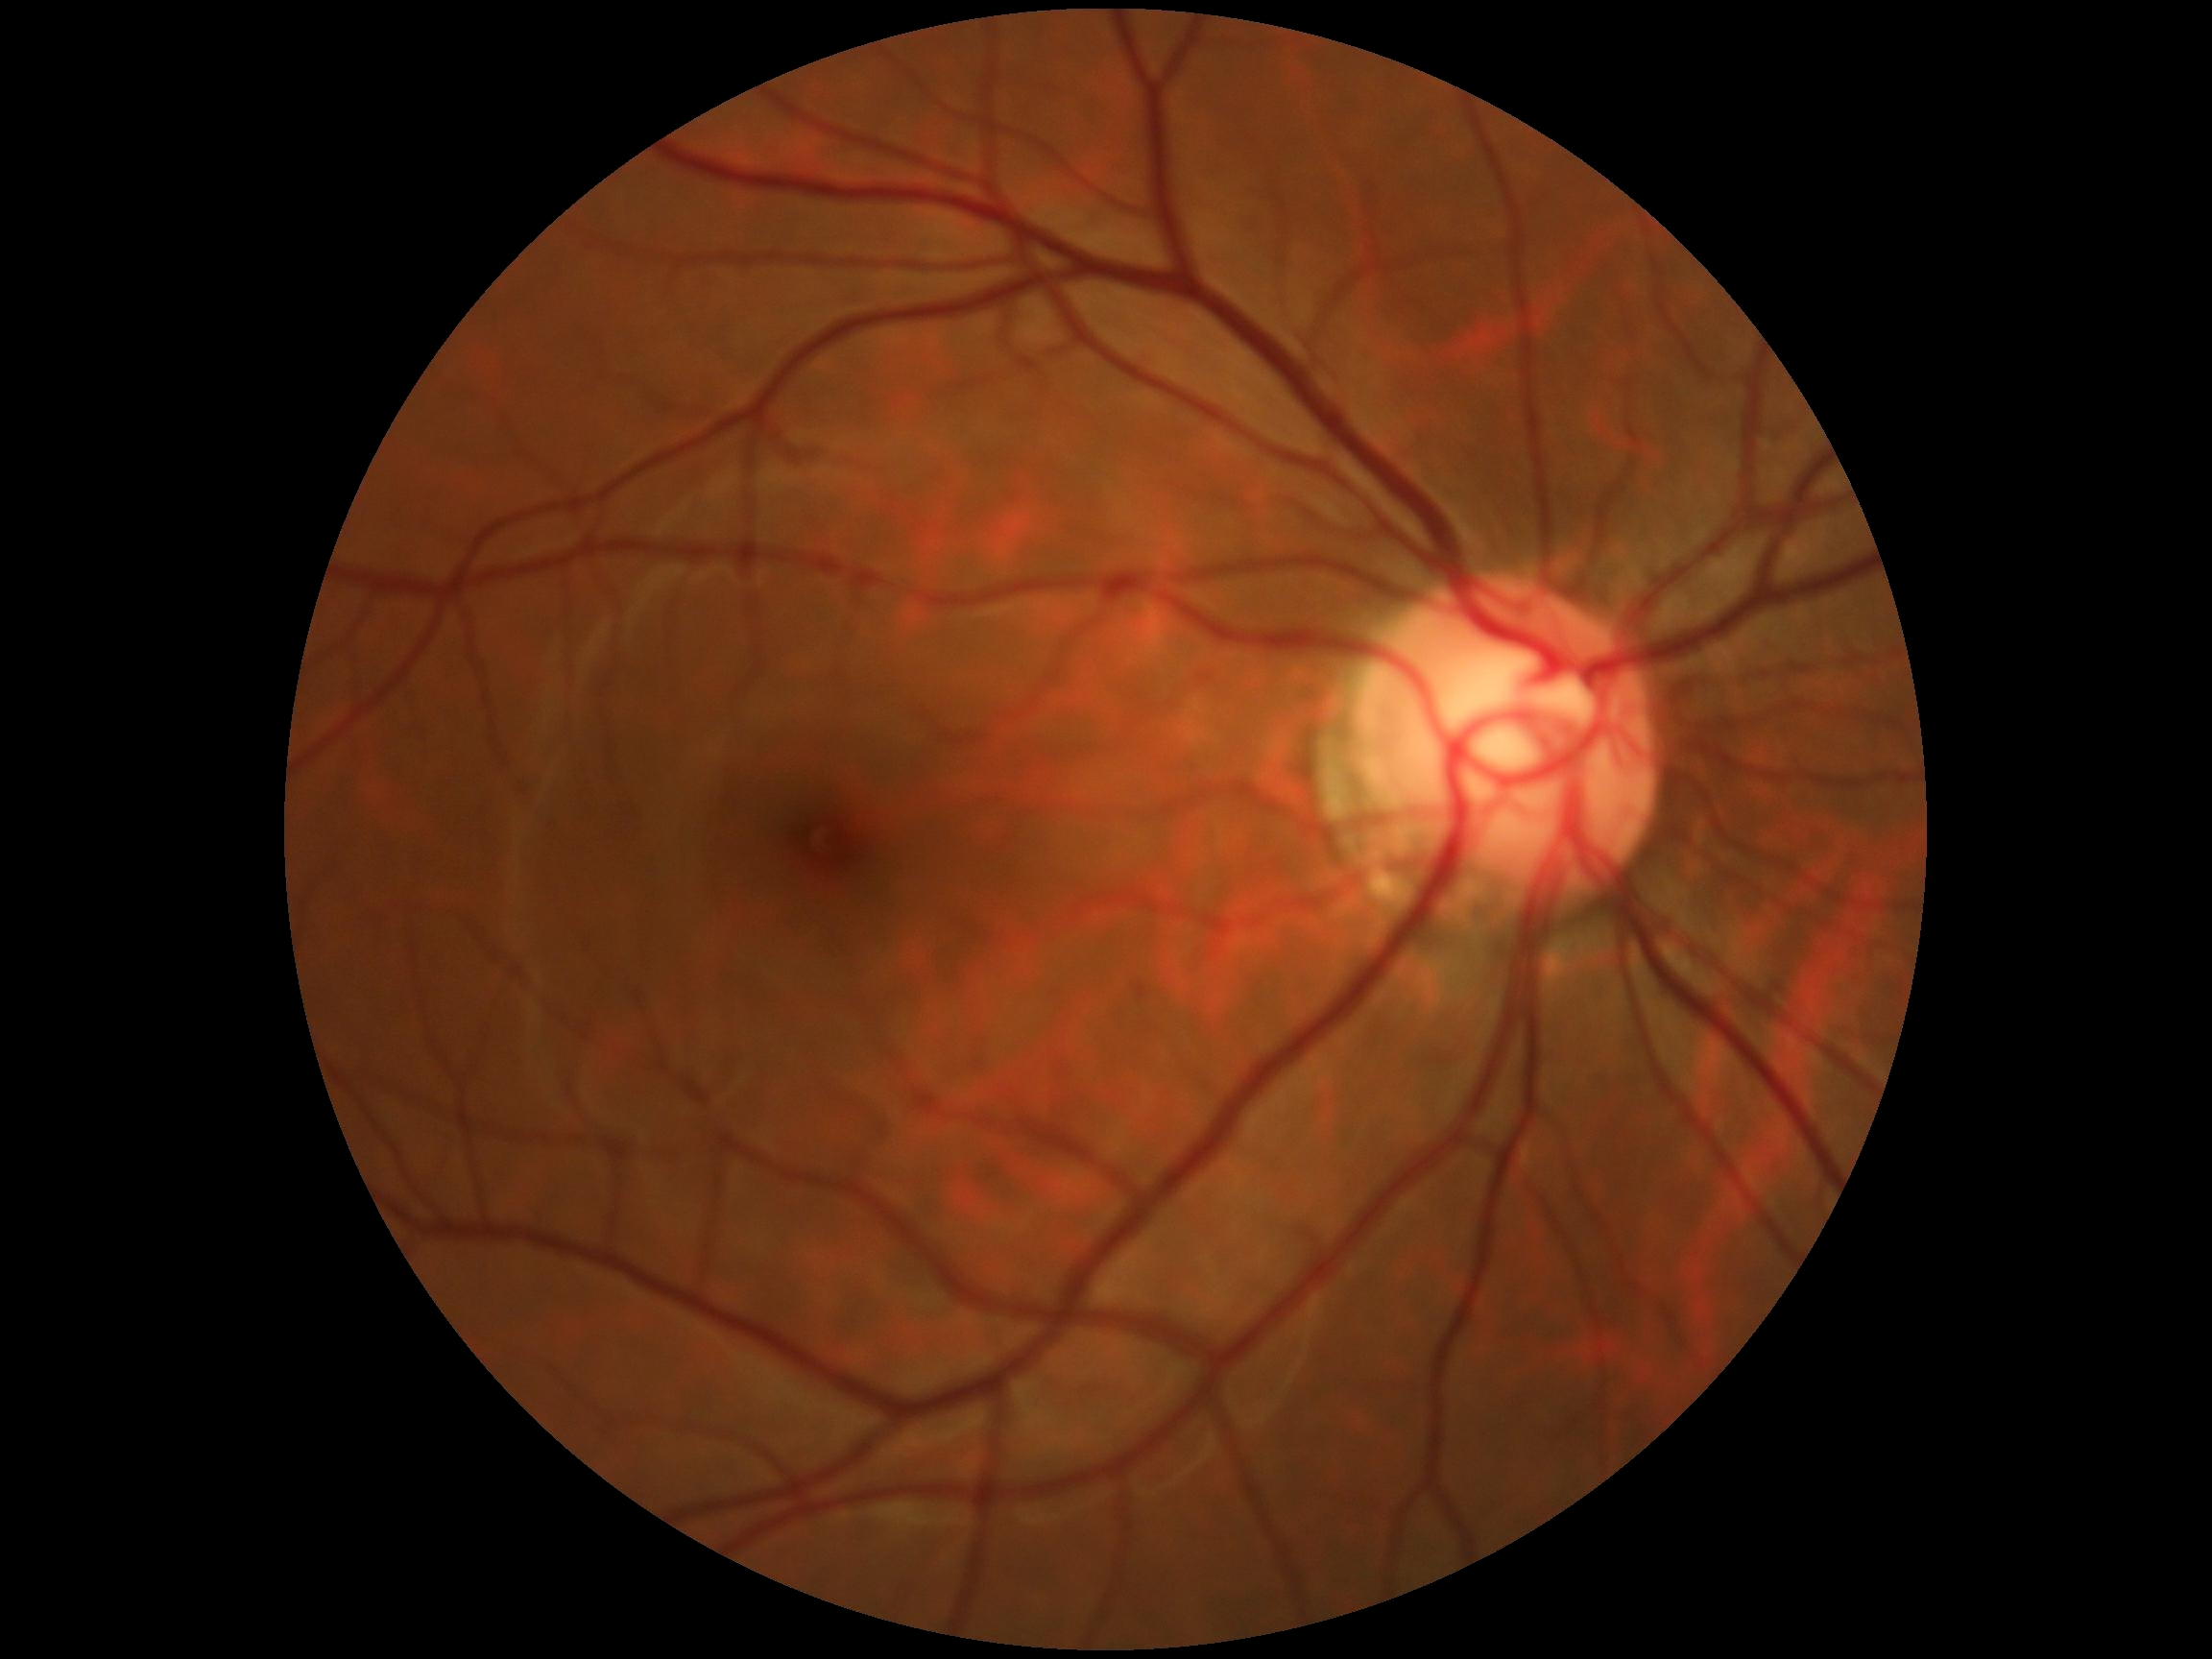 No apparent diabetic retinopathy. DR is grade 0 (no apparent retinopathy).